Fundus photo.
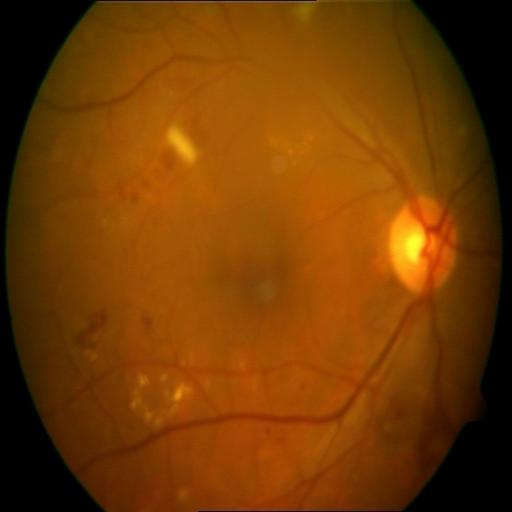 Demonstrates cotton wool spots & hemorrhagic retinopathy.